Wide-field fundus image from infant ROP screening: 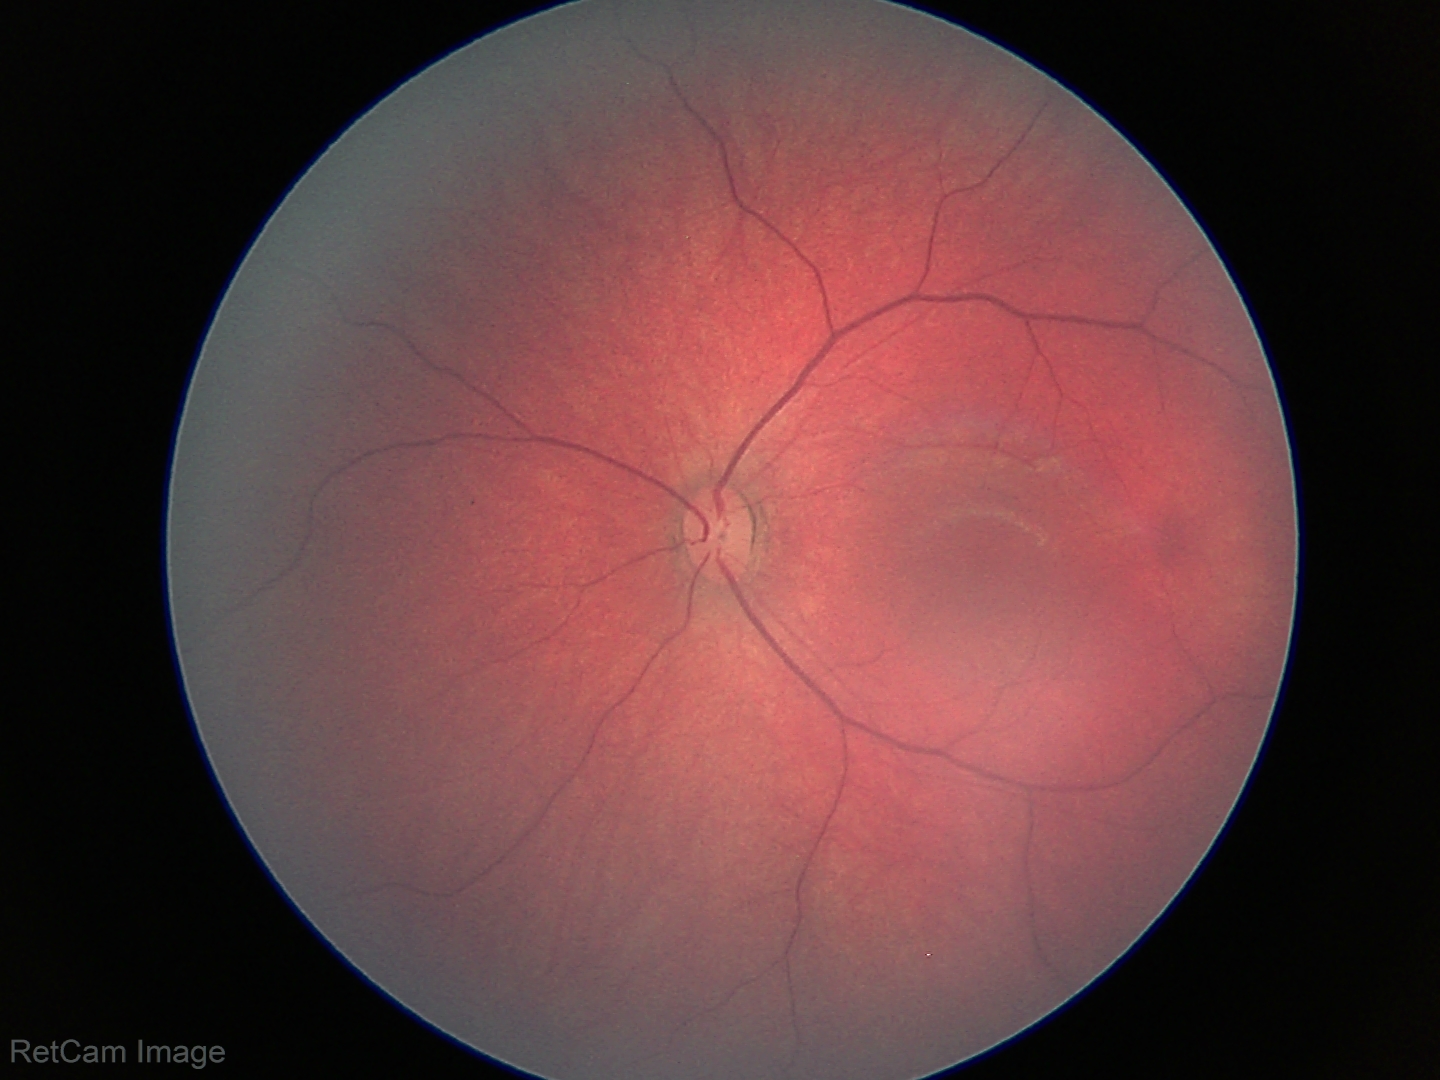
Physiological retinal appearance for postconceptual age.